2048x1536, color fundus image — 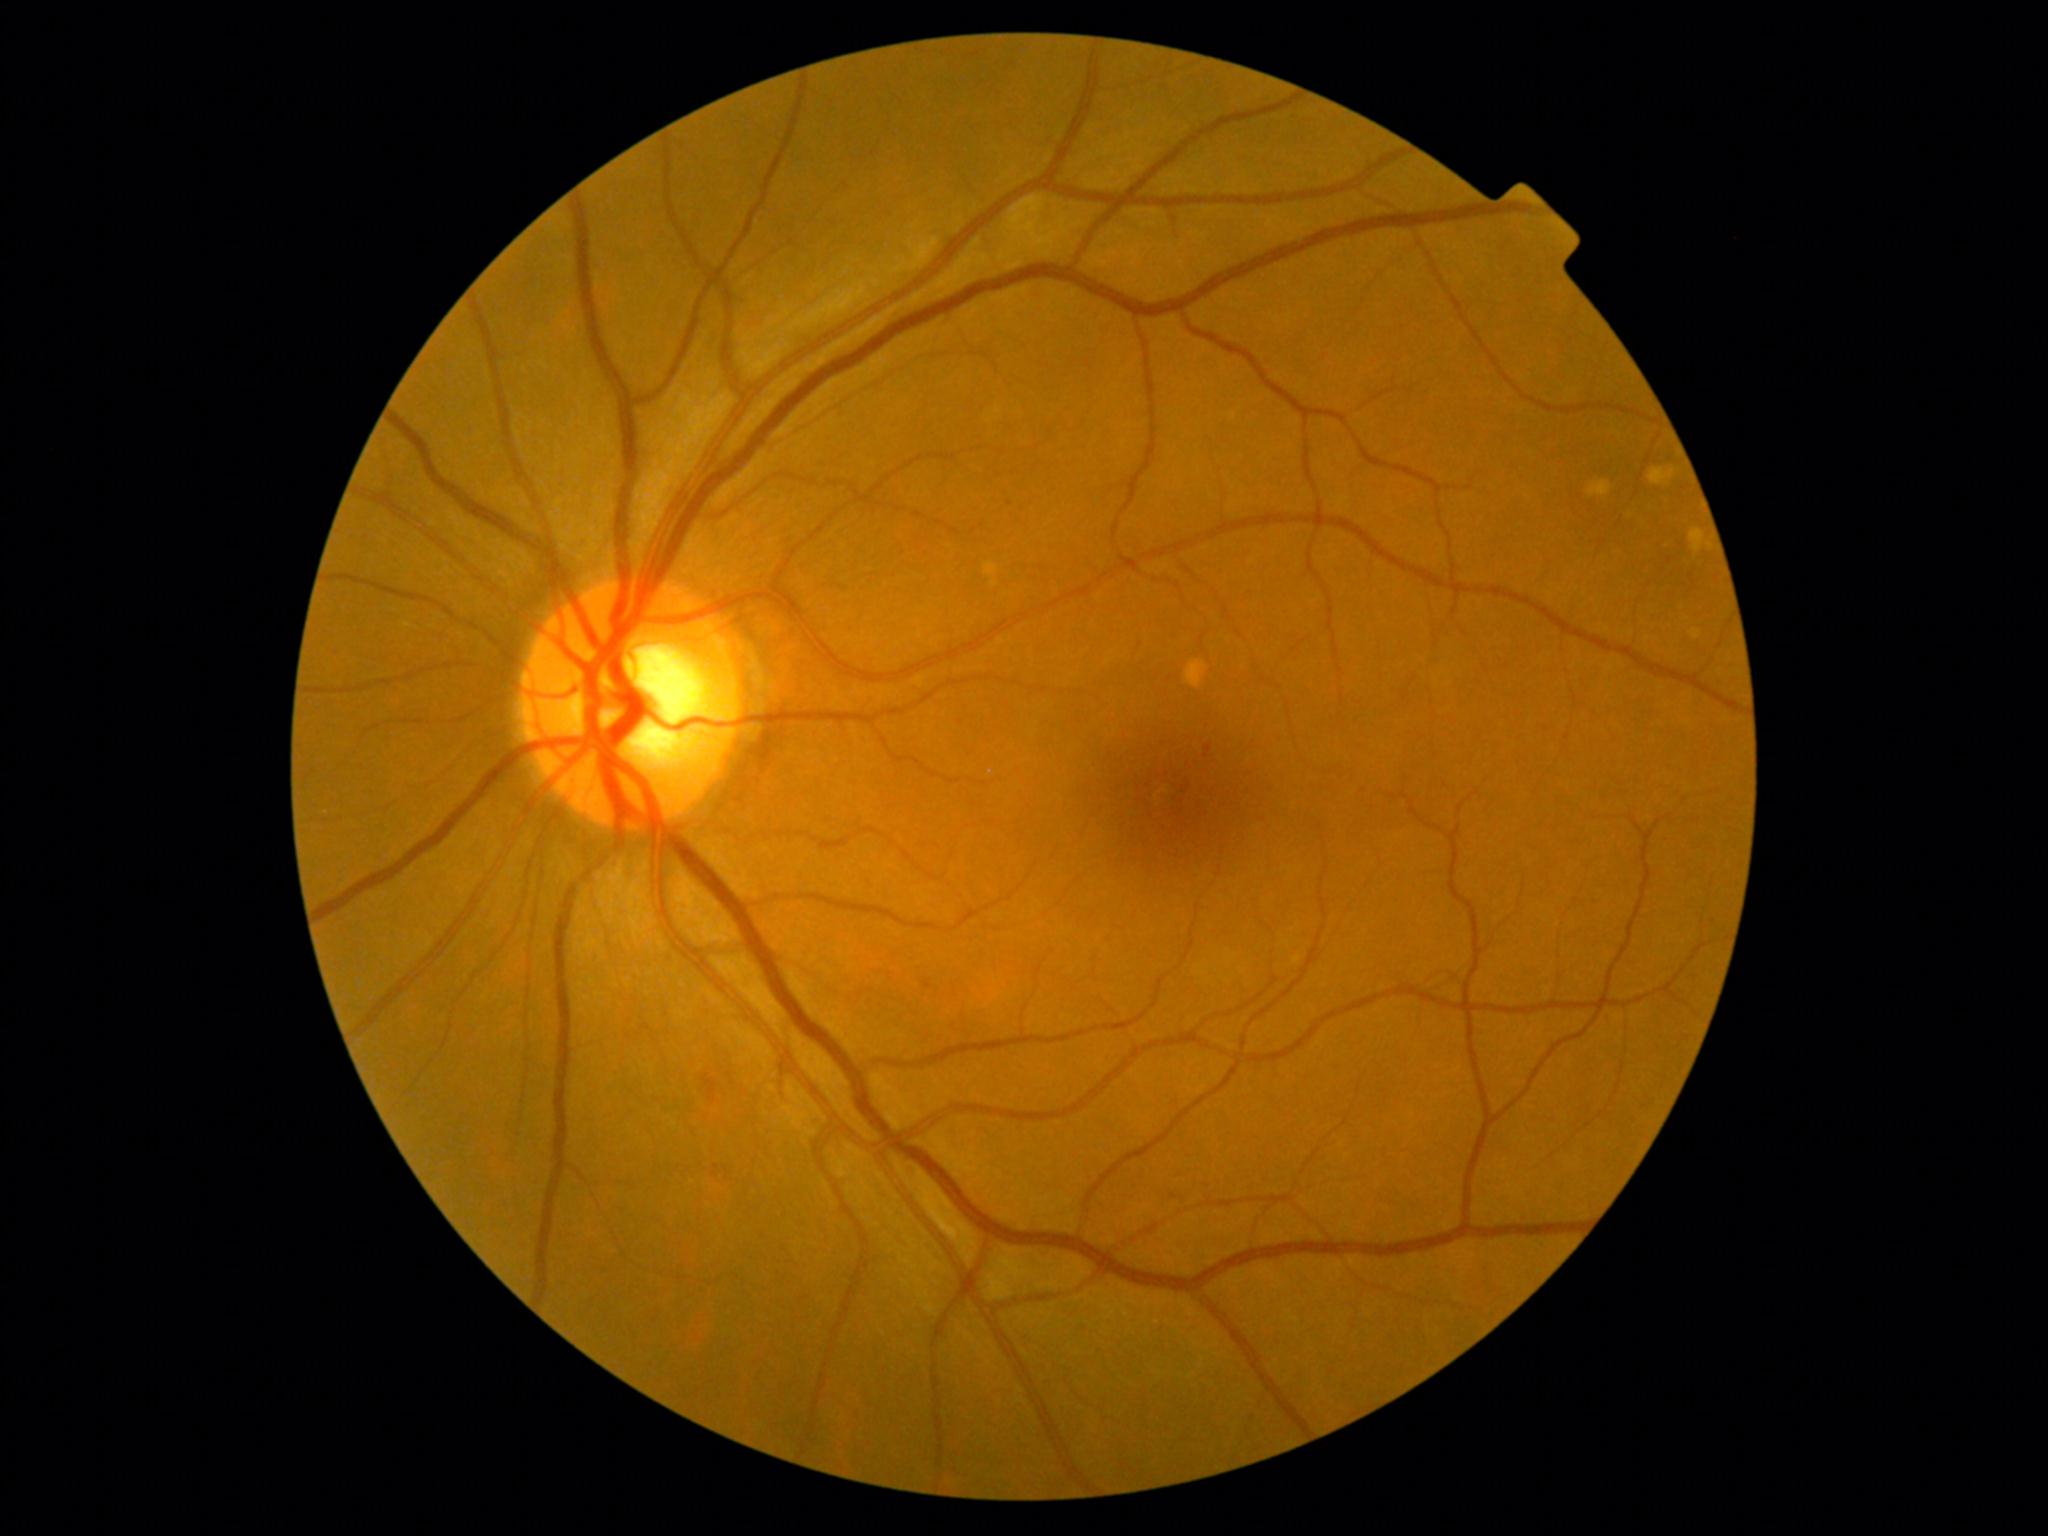
* diabetic retinopathy grade — 1 — presence of microaneurysms only